Davis DR grading · nonmydriatic:
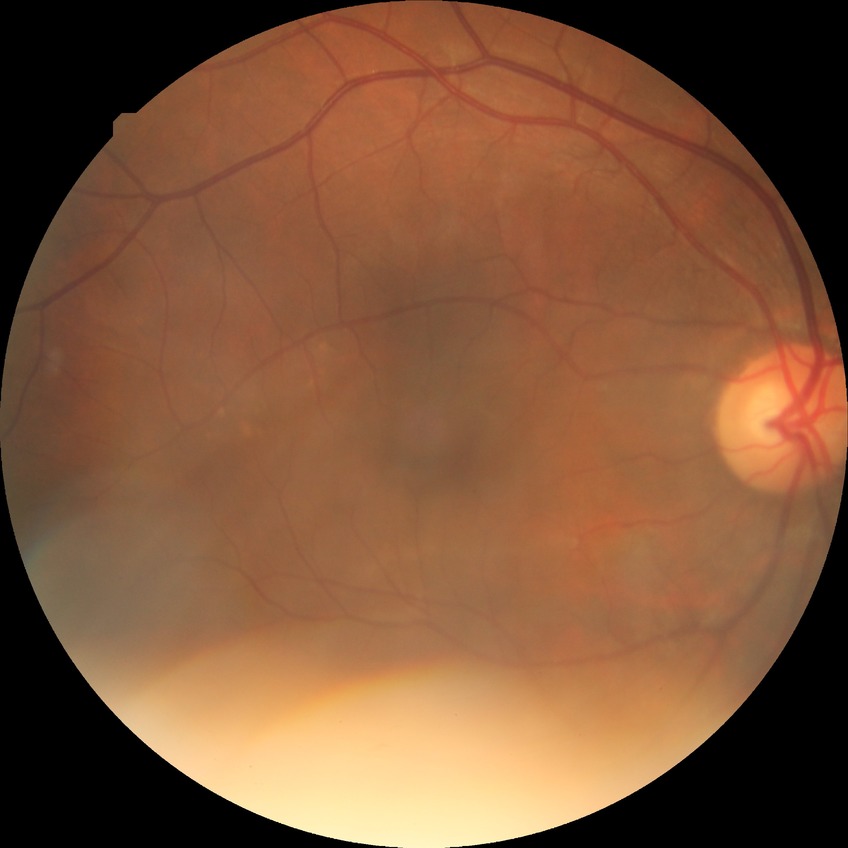

diabetic retinopathy (DR): NDR (no diabetic retinopathy).